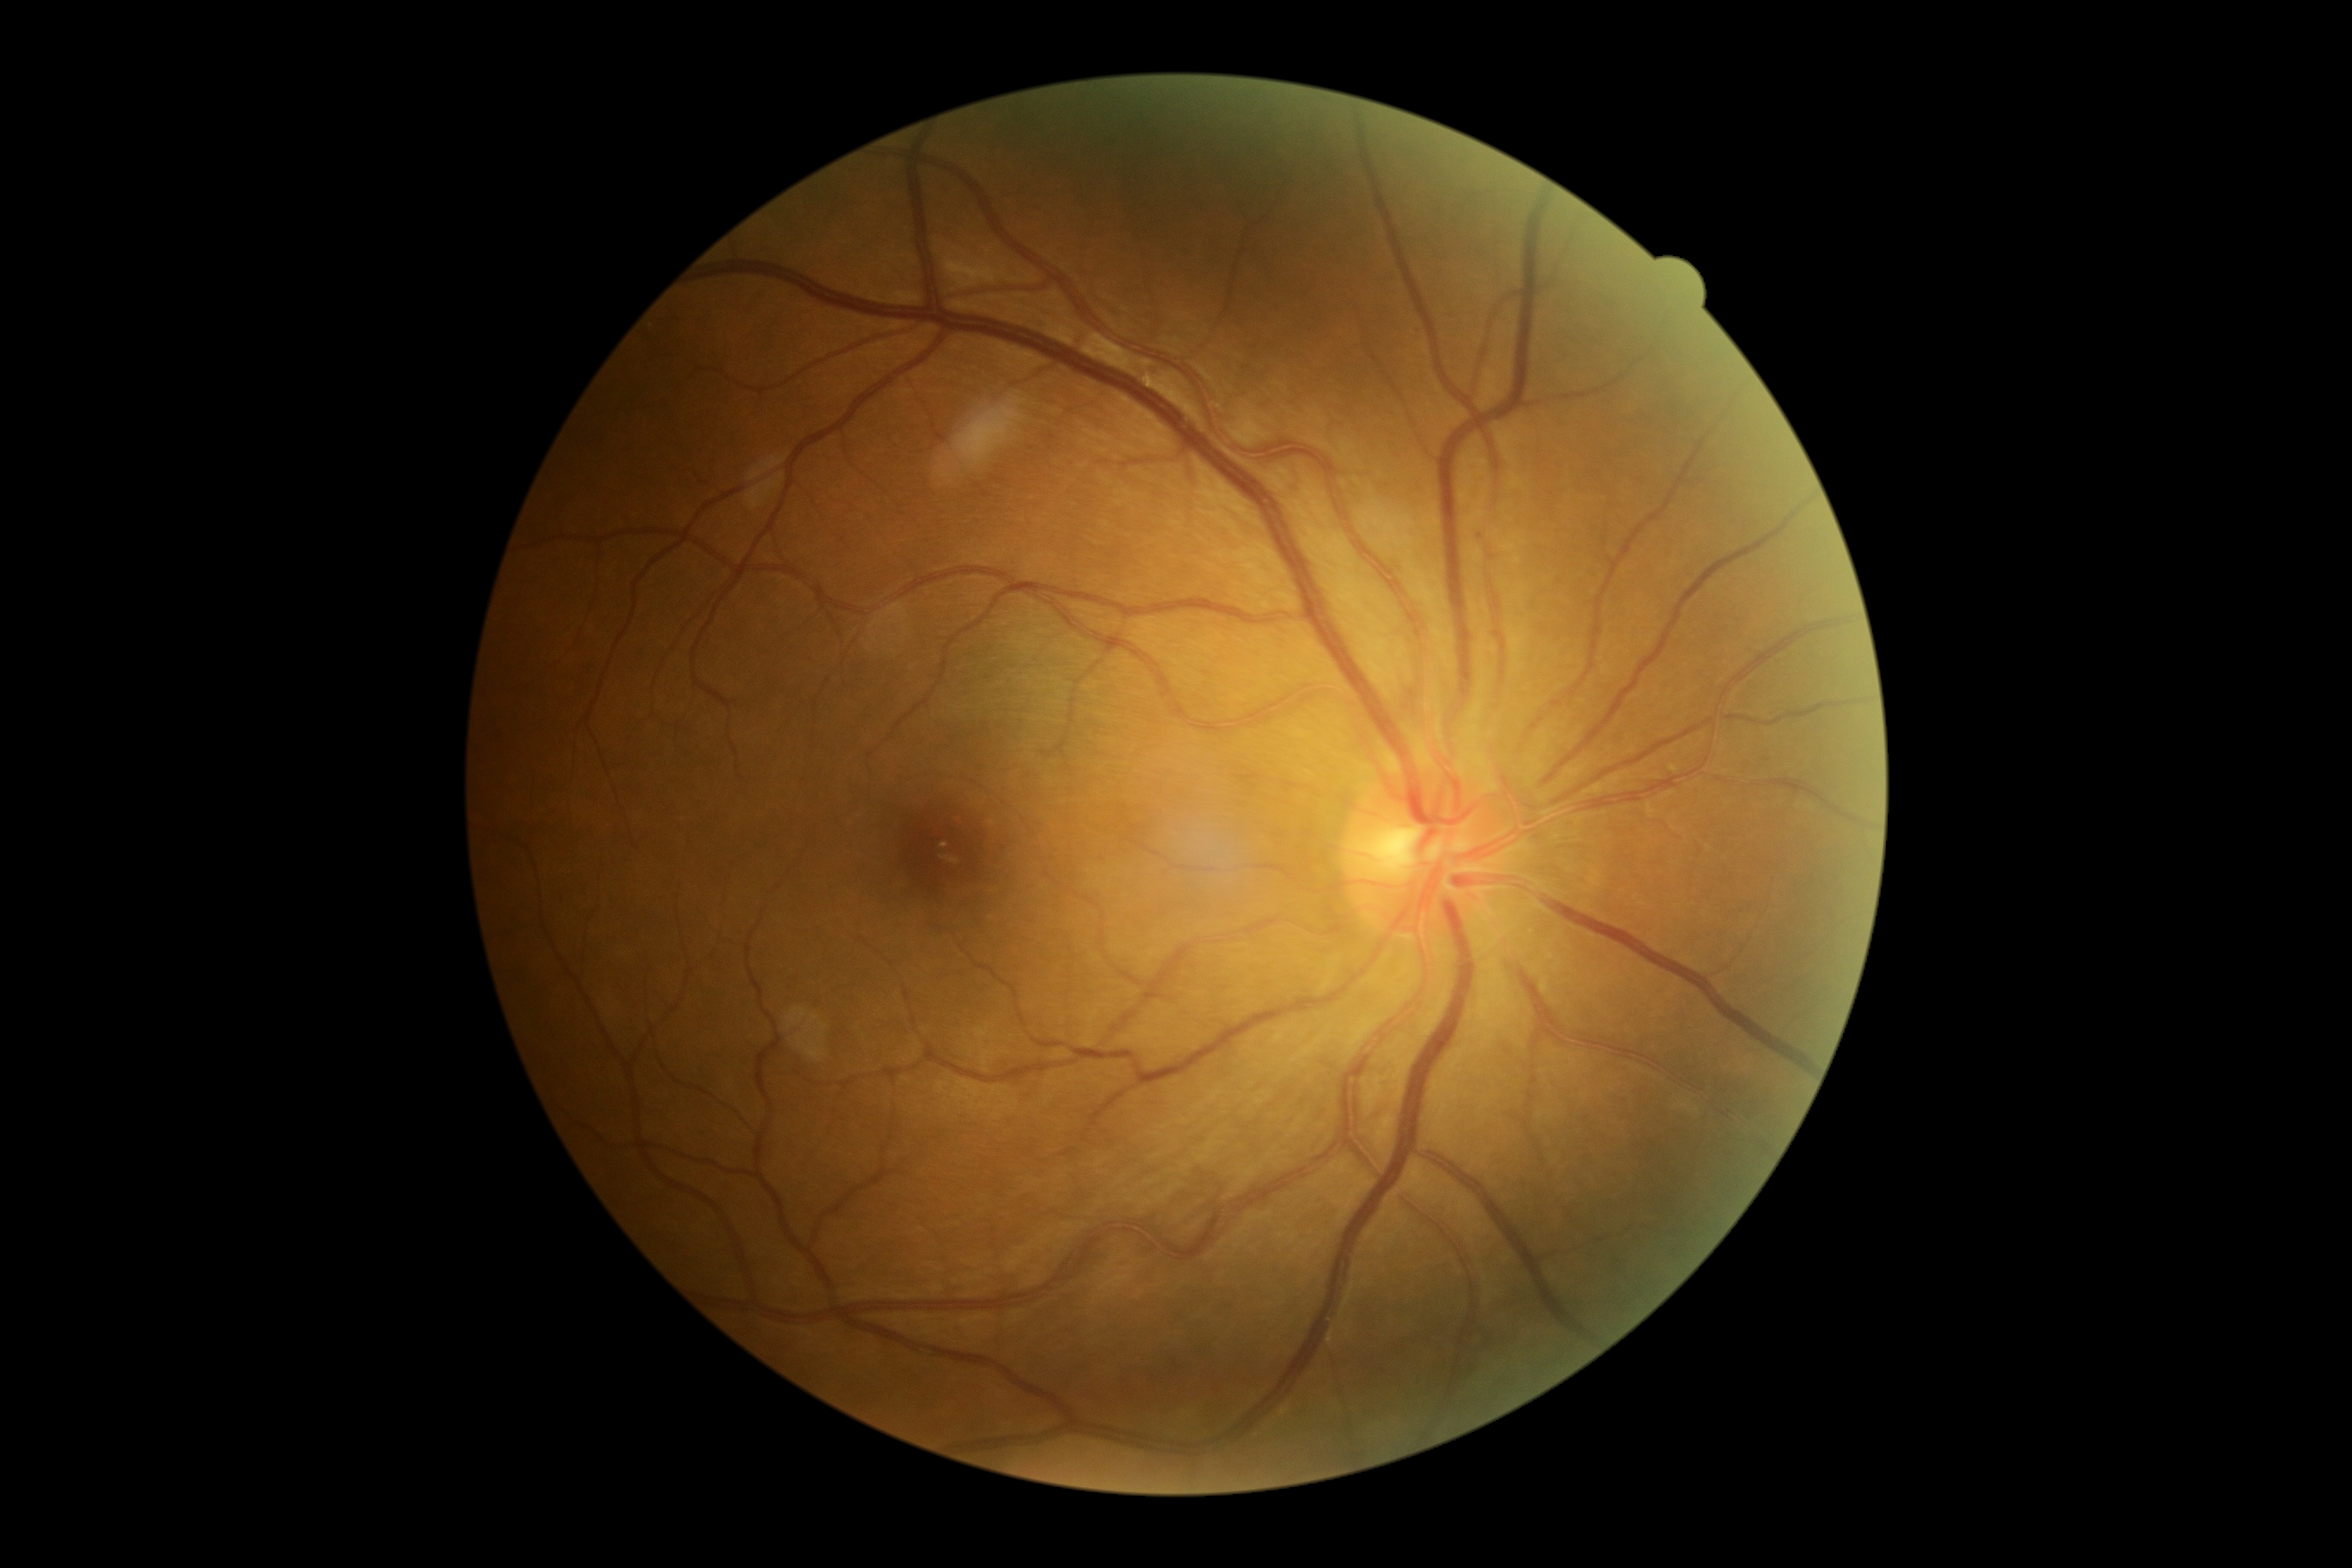

DR grade is 1 (mild NPDR).